Davis DR grading:
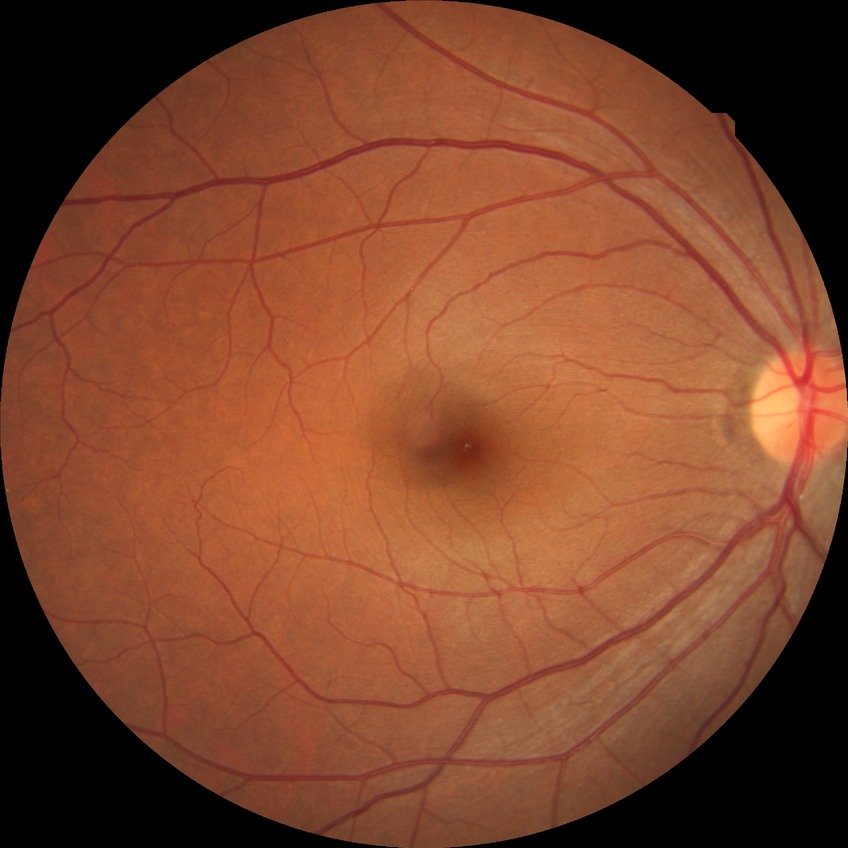

Diabetic retinopathy (DR): no diabetic retinopathy (NDR).